45° FOV
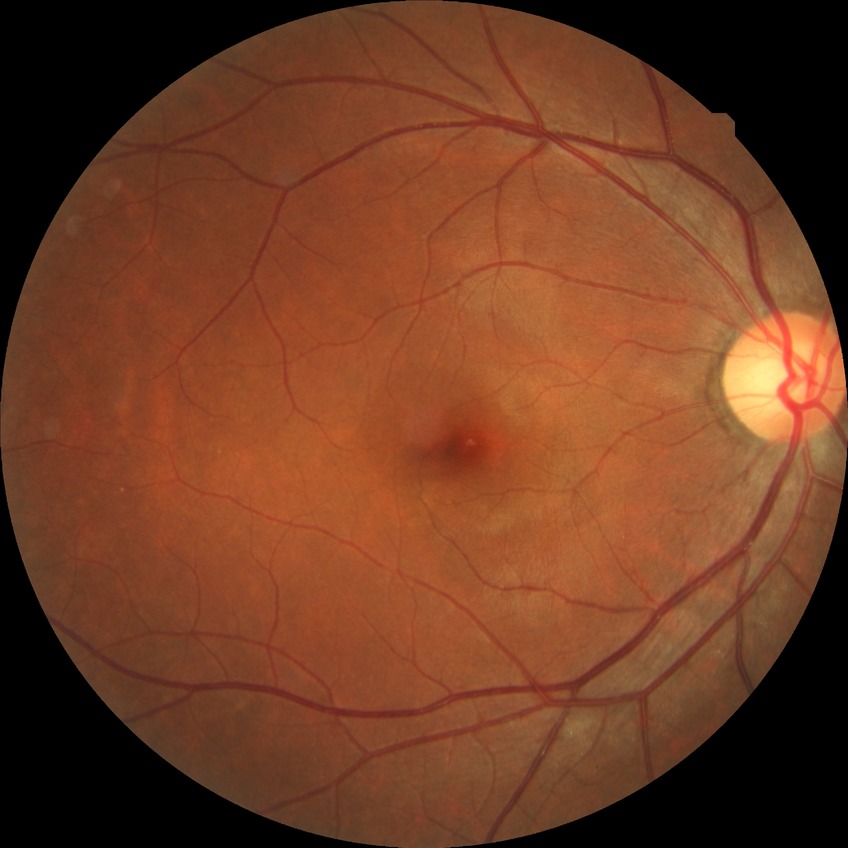 Diabetic retinopathy (DR): NDR (no diabetic retinopathy).